Ultra-widefield fundus mosaic, 1924x1556:
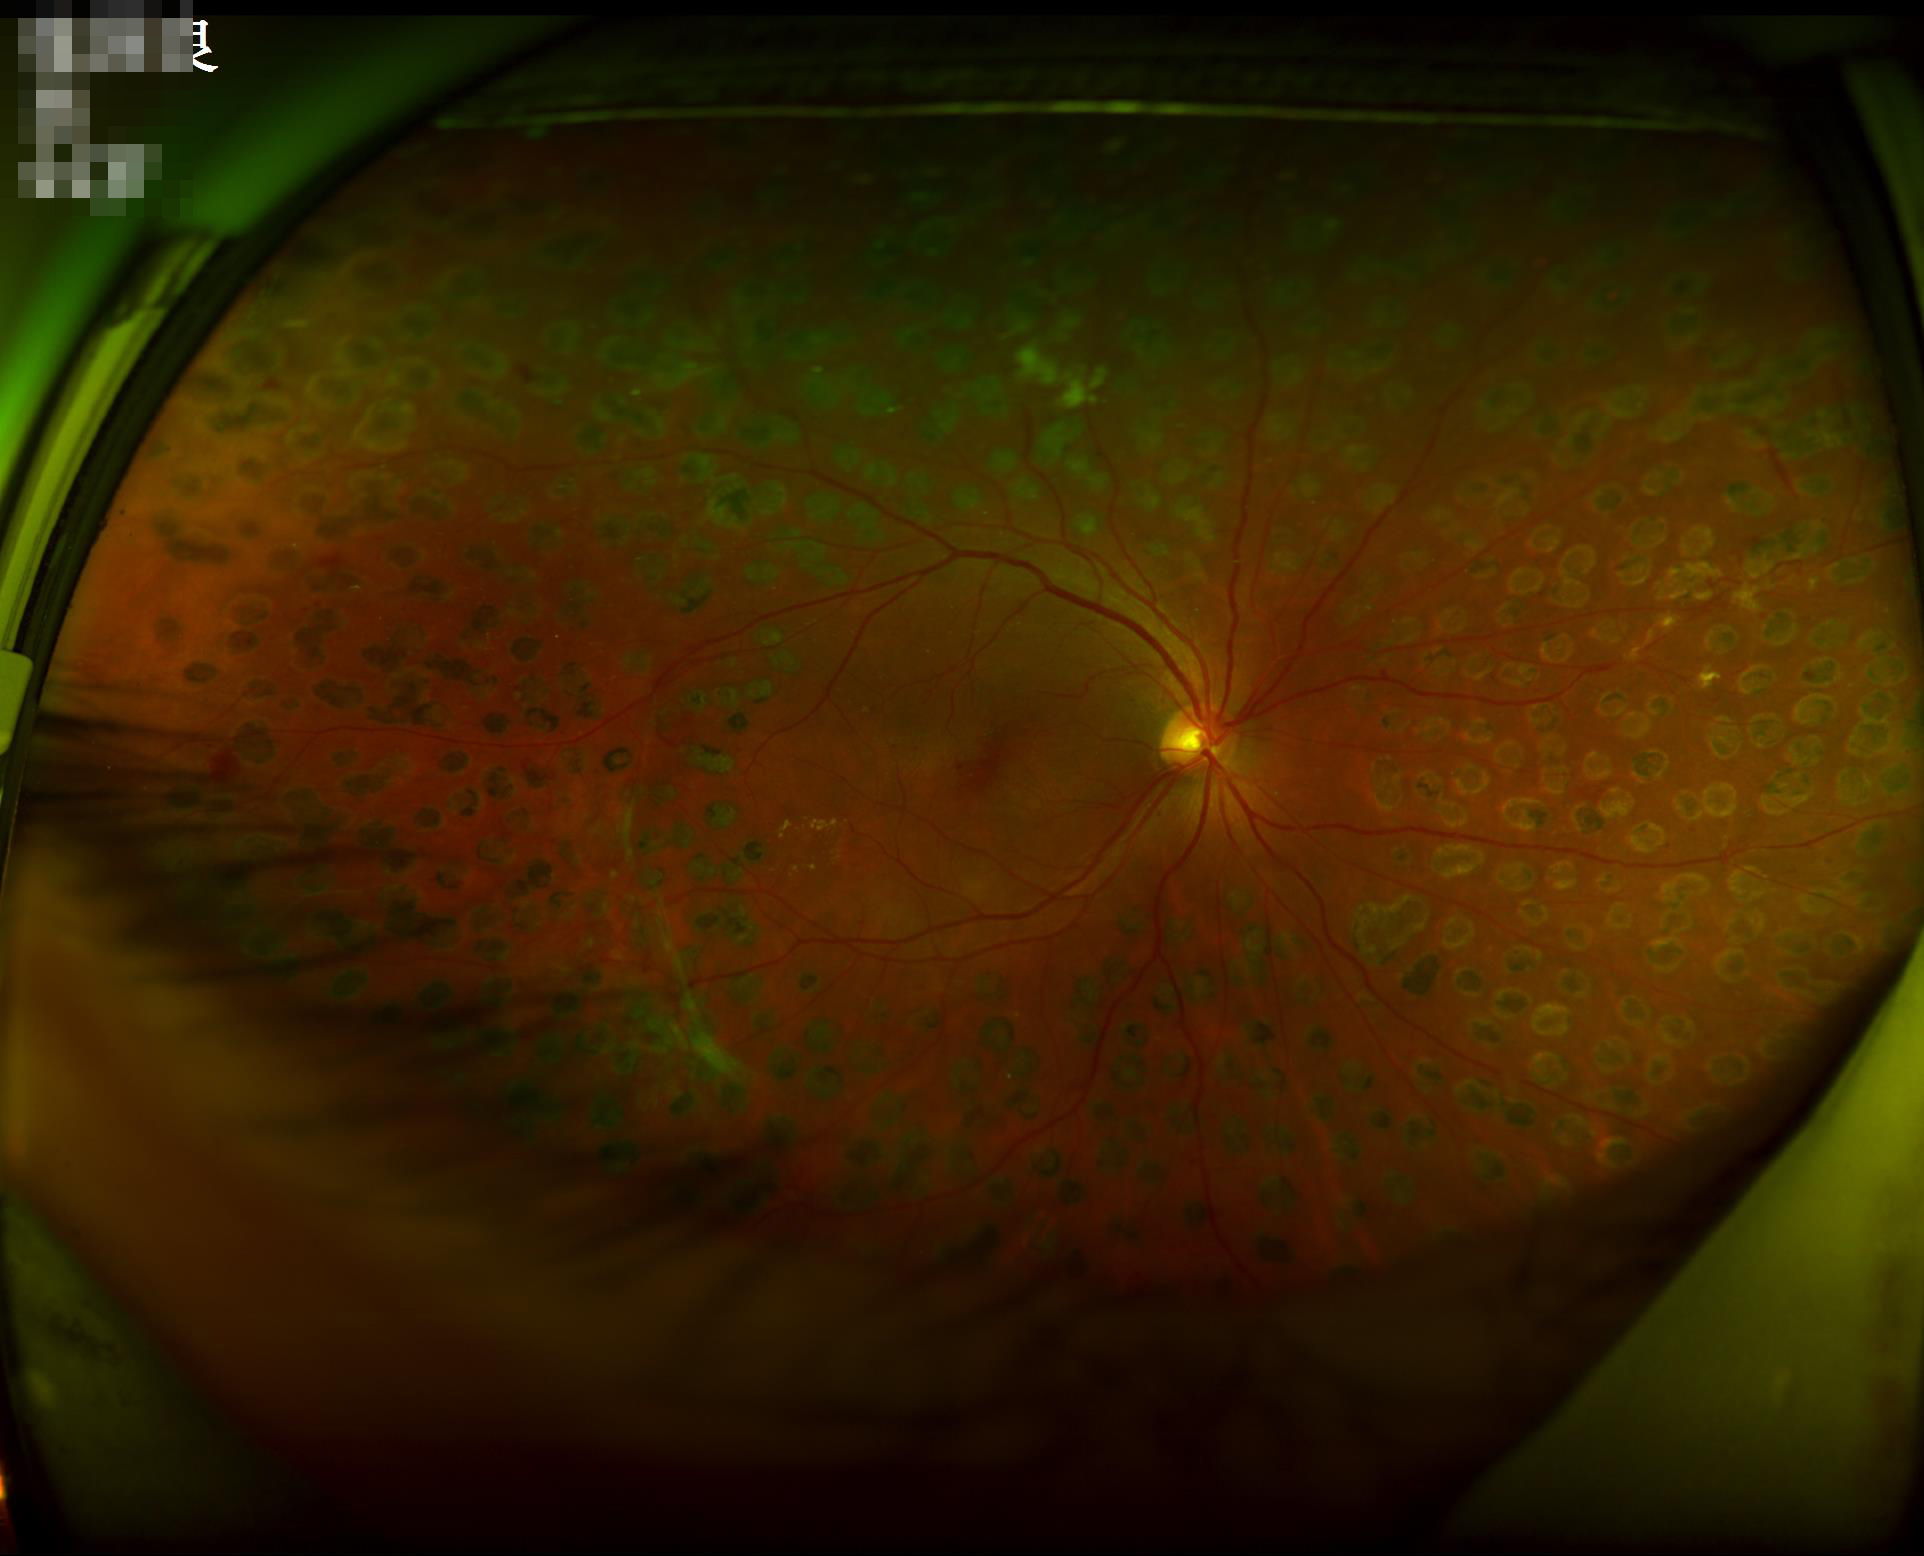
Overall quality is good and the image is gradable. Illumination is even. Reduced sharpness with visible blur. Adequate contrast for distinguishing structures.